Image size 2346x1568 · 45° field of view — 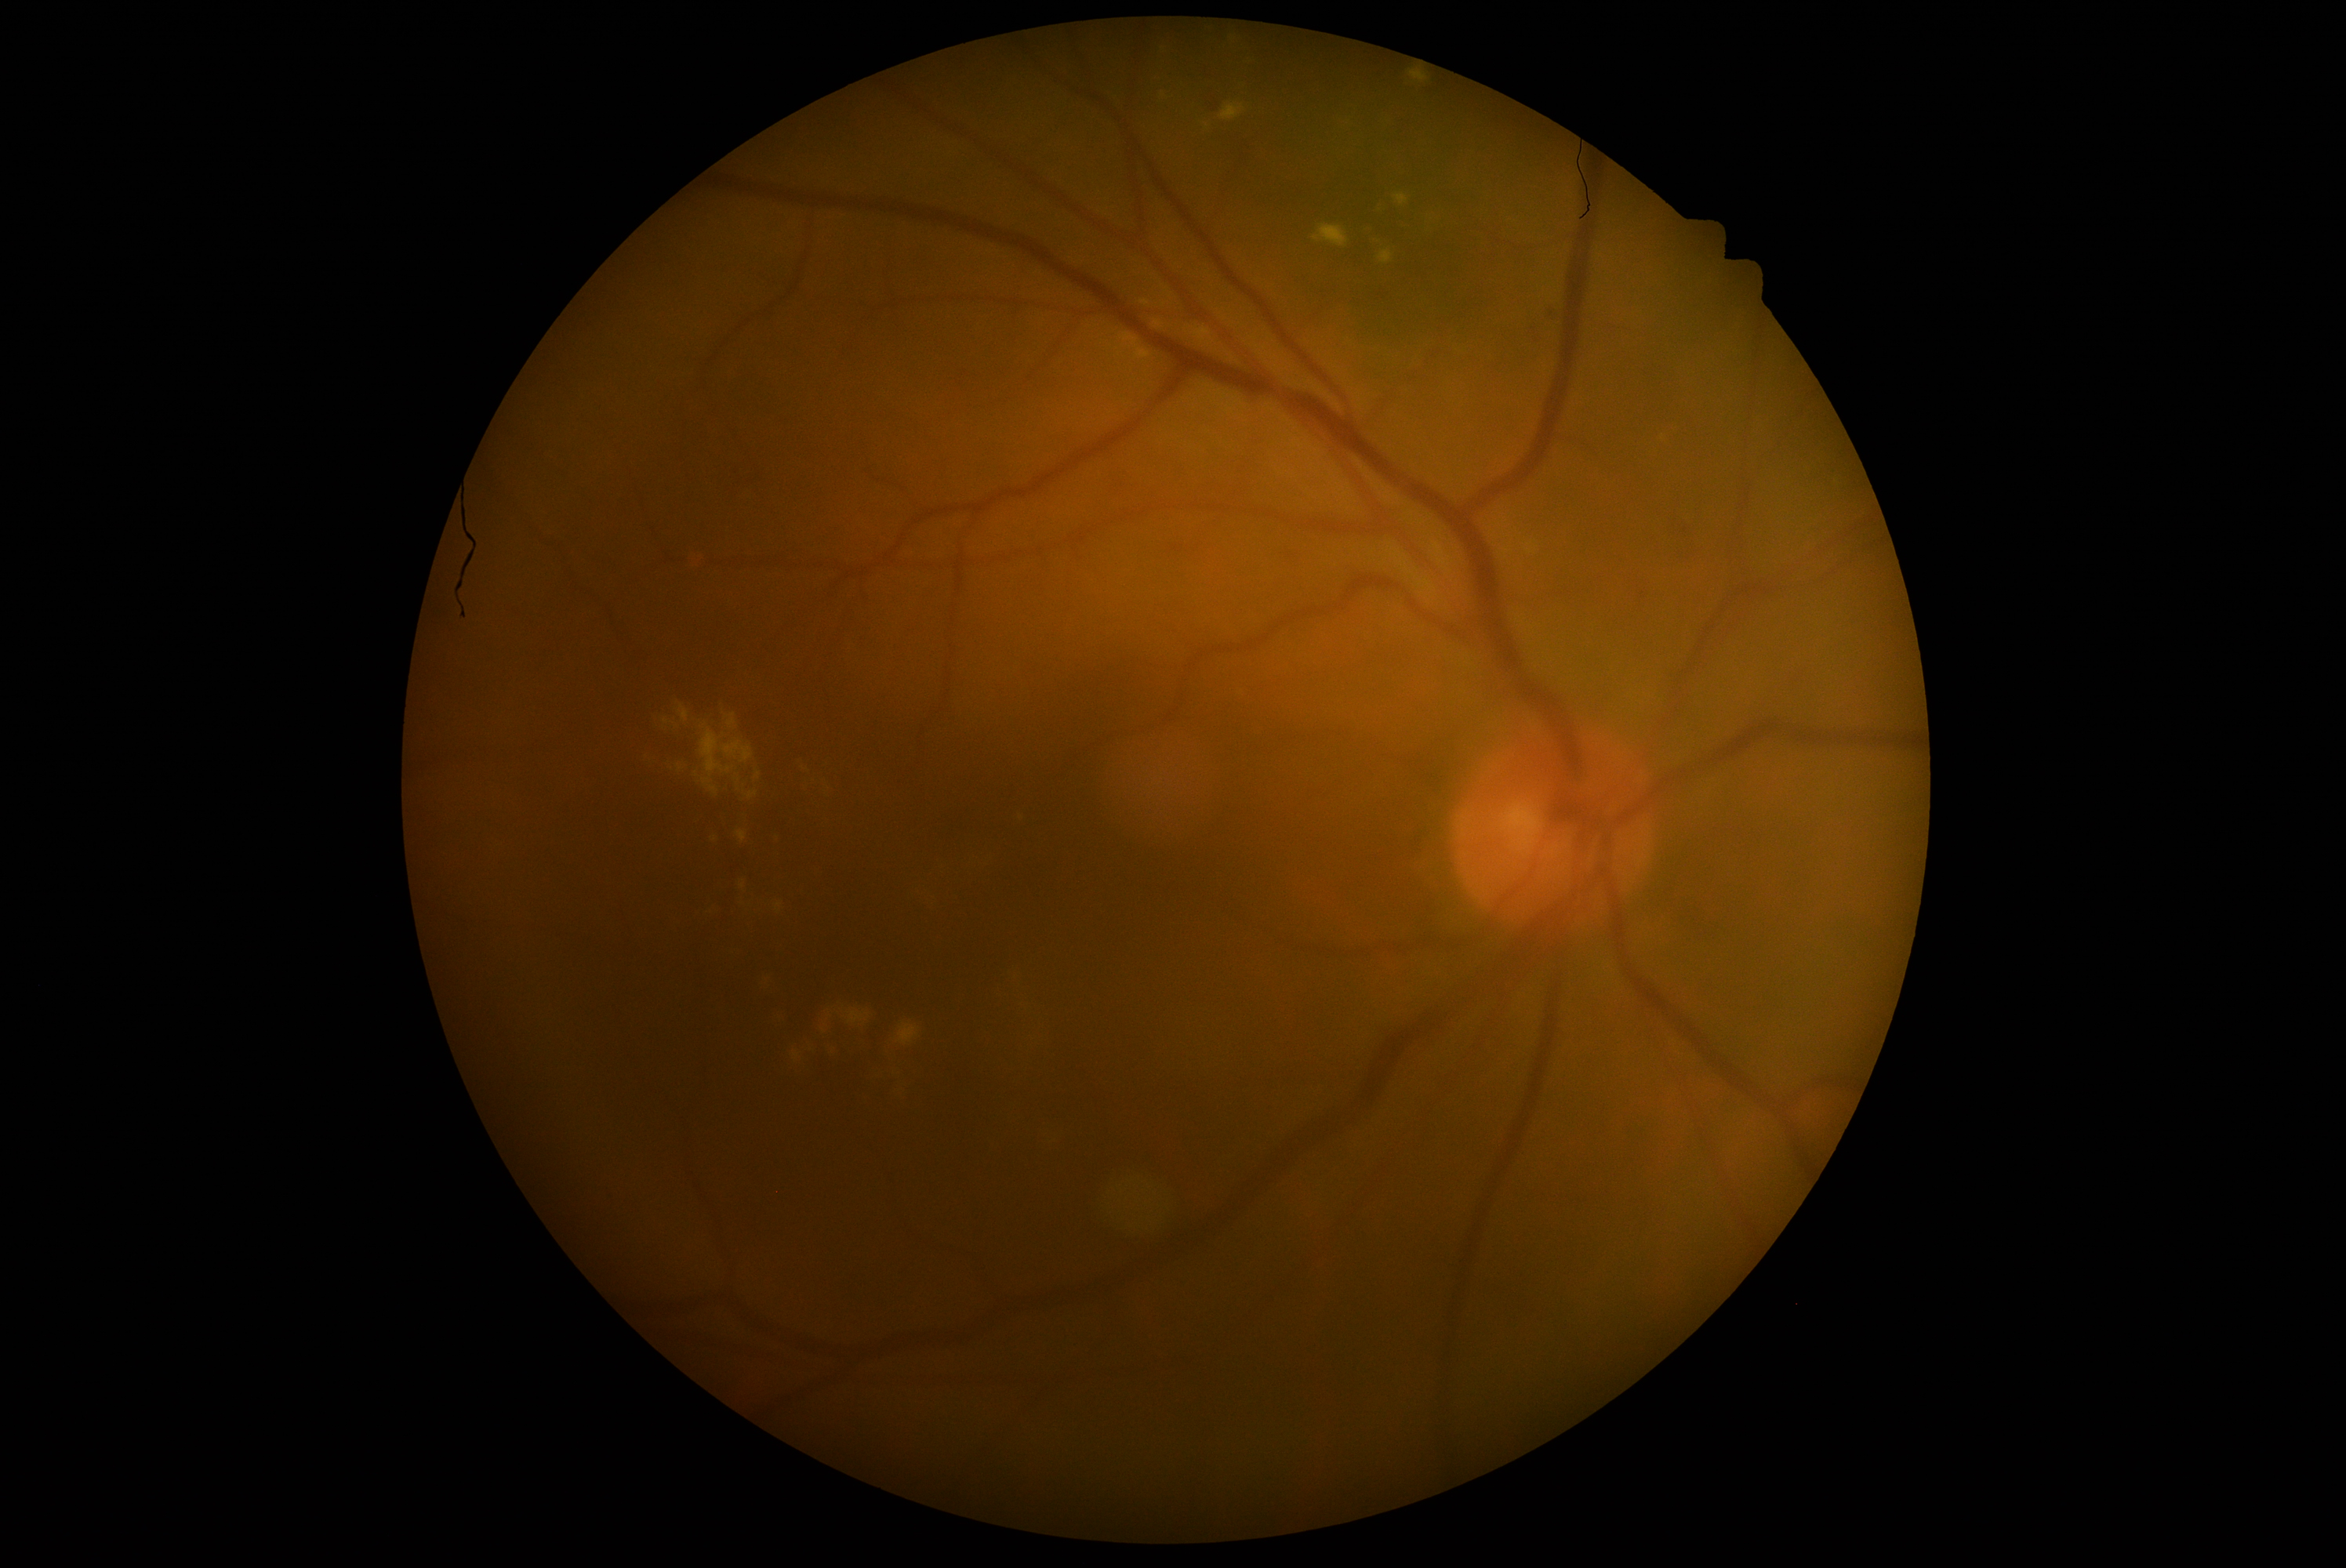 Findings:
– DR severity — grade 2 (moderate NPDR)